2048x1536, 45° field of view, color fundus photograph
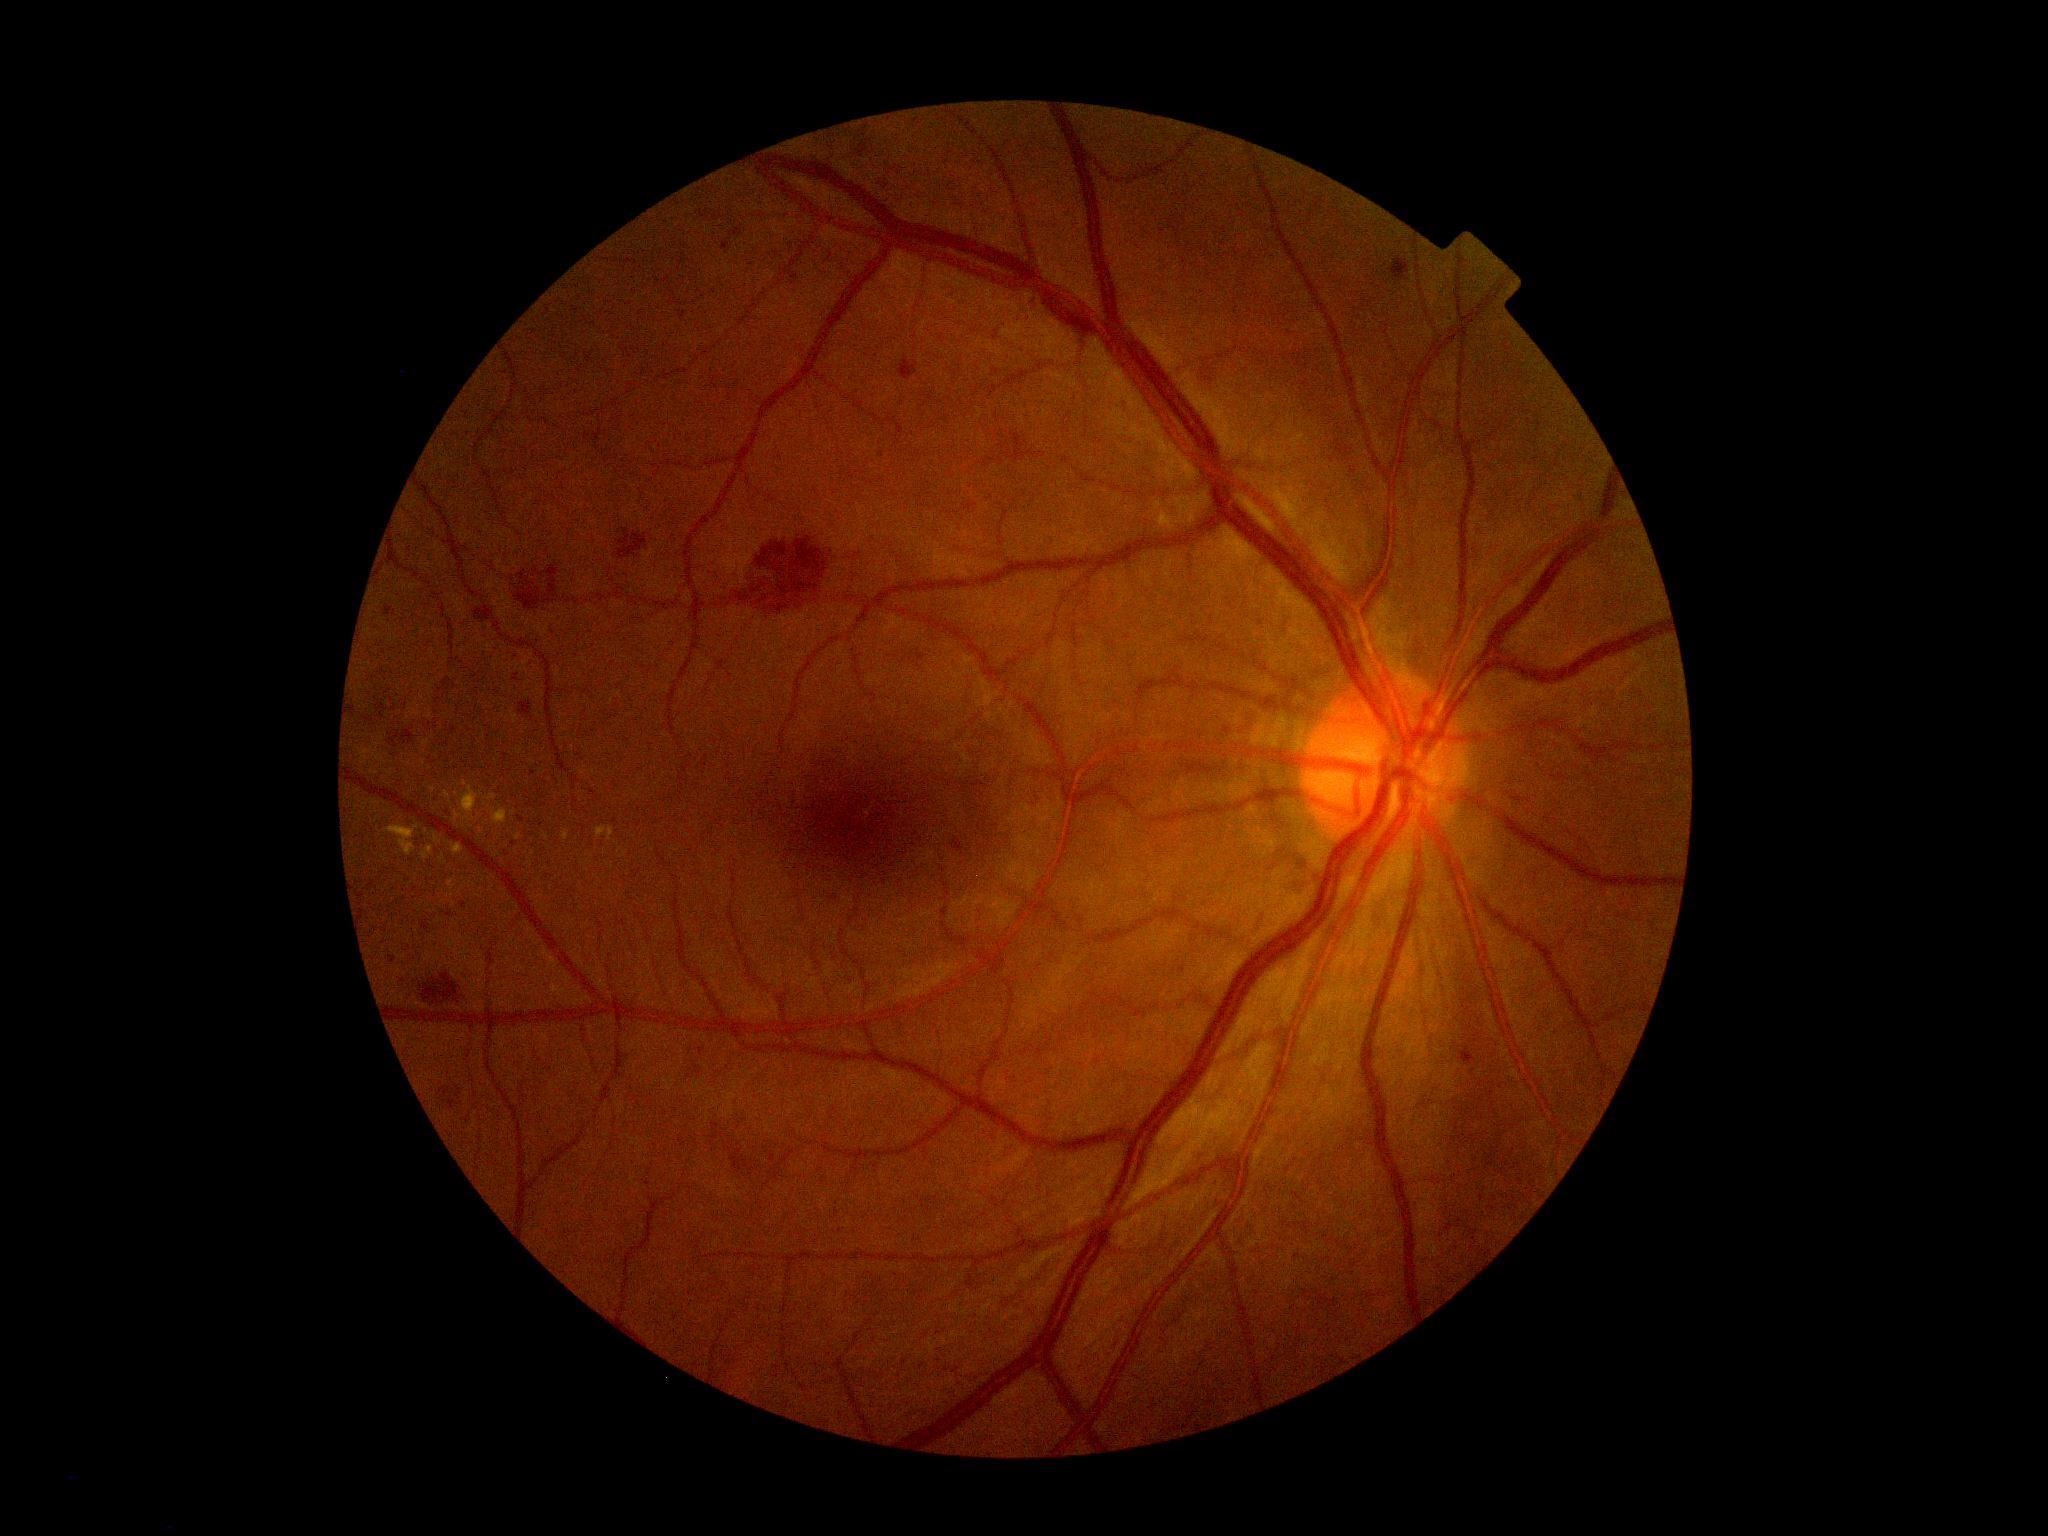
Diabetic retinopathy (DR) is grade 2 (moderate NPDR).